2048x1536px; retinal fundus photograph — 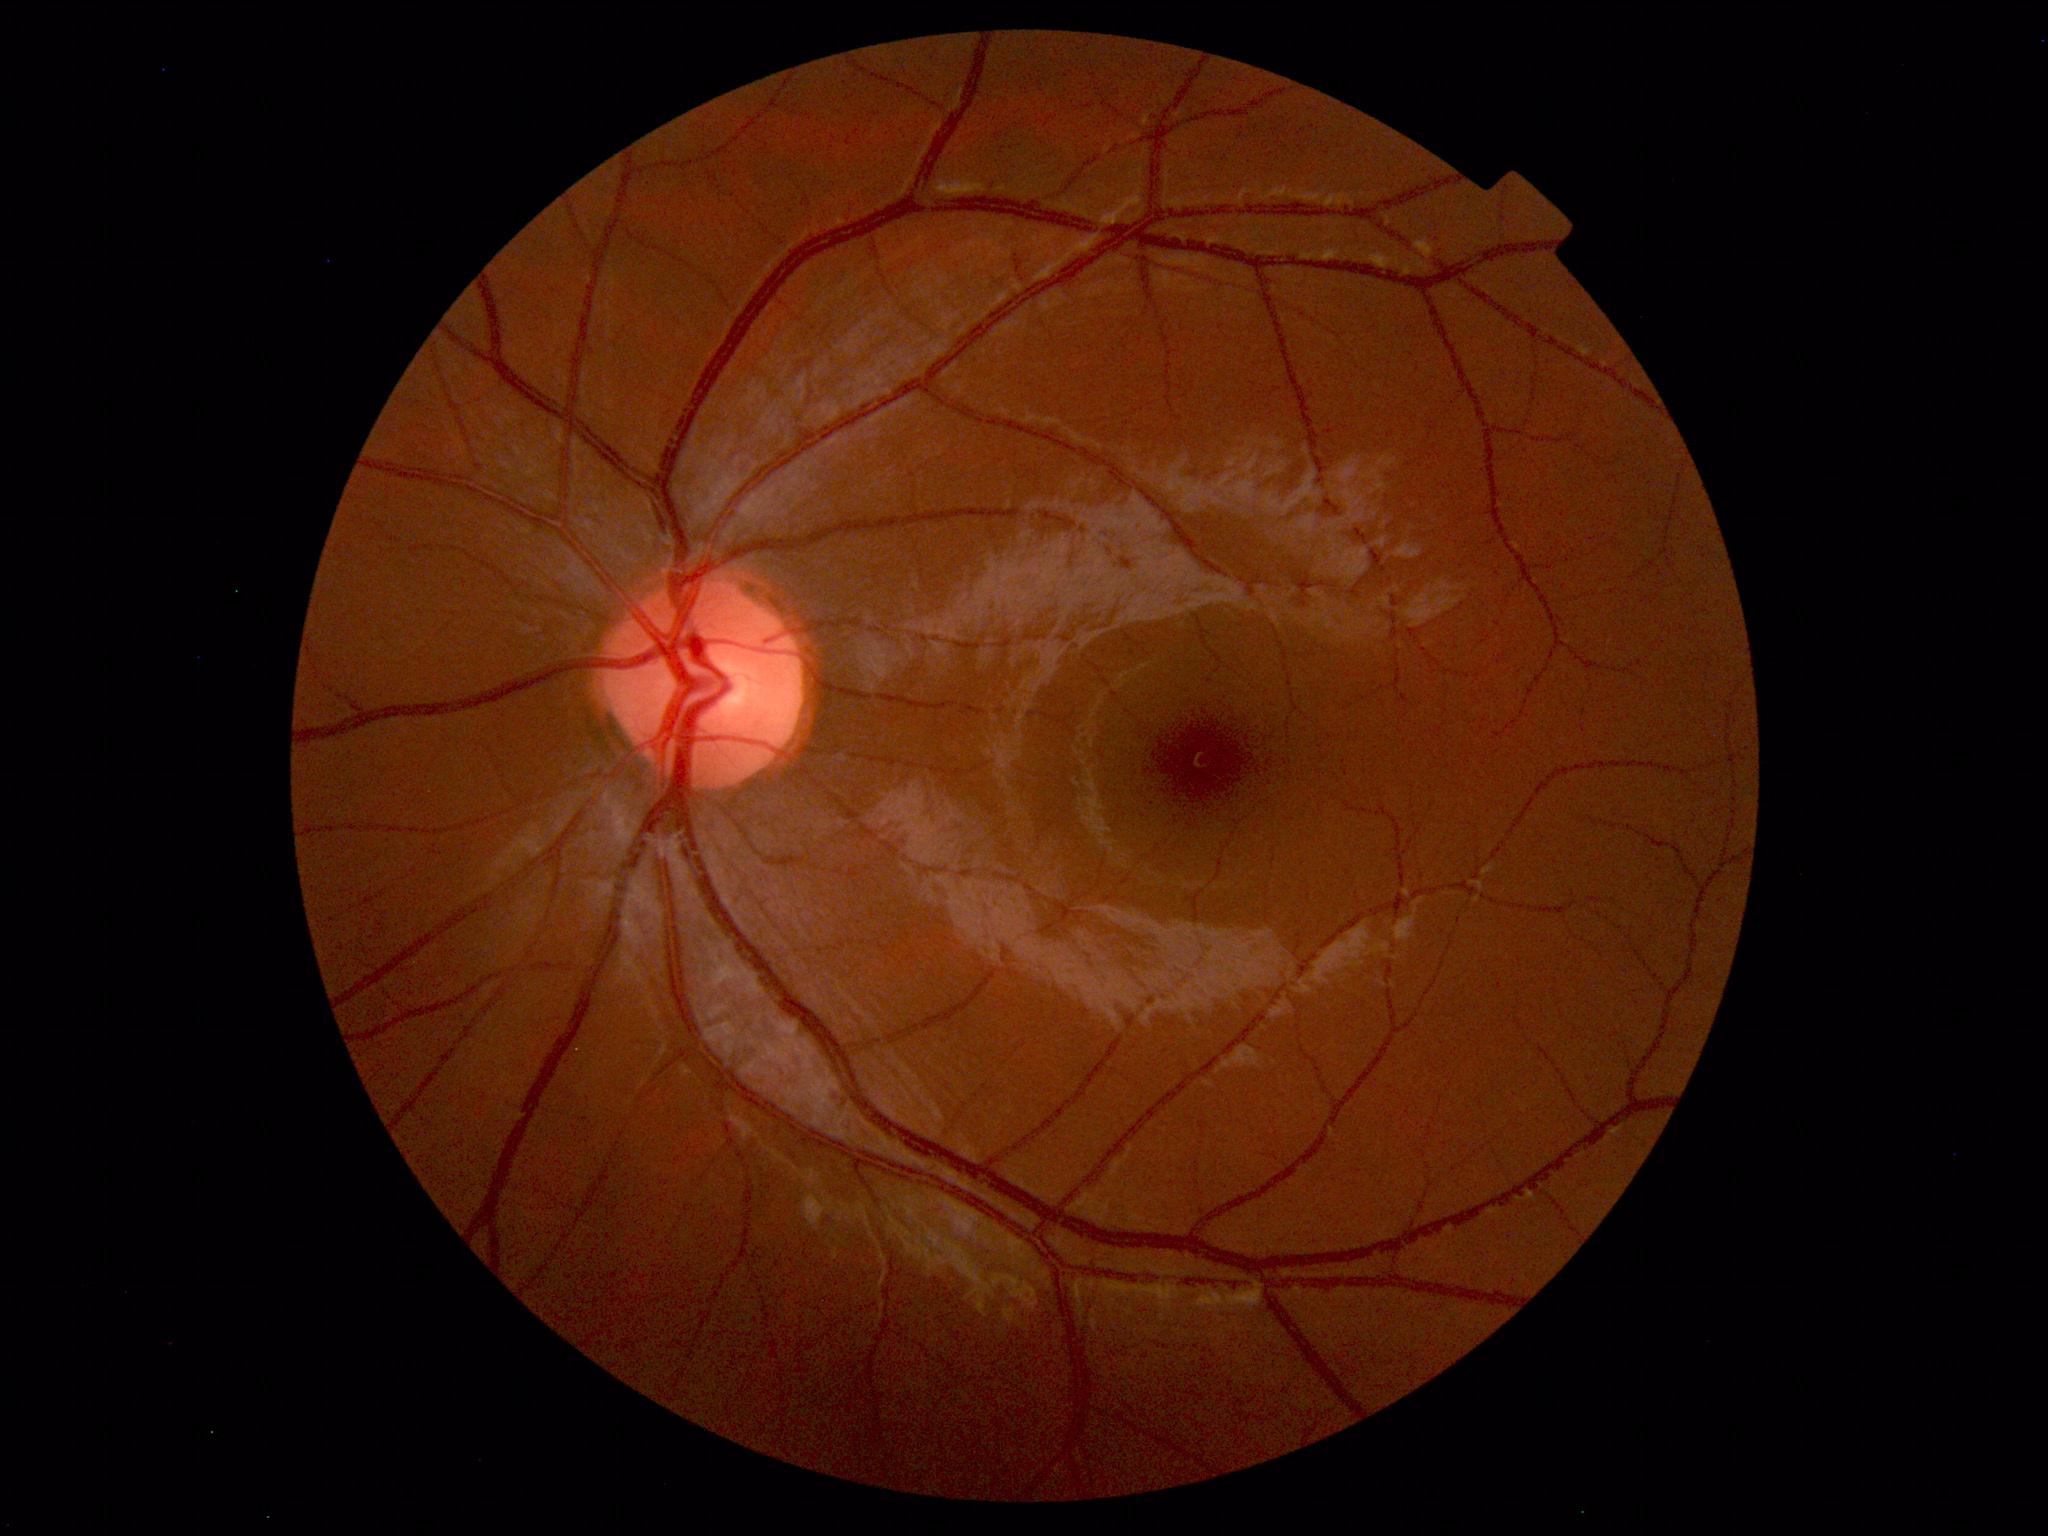

Impression: normal fundus.